Captured with the Clarity RetCam 3 (130° field of view) · wide-field contact fundus photograph of an infant.
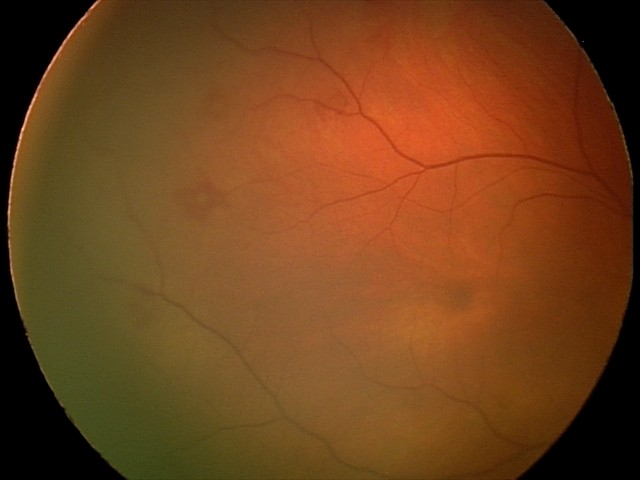
Impression: retinal hemorrhages.